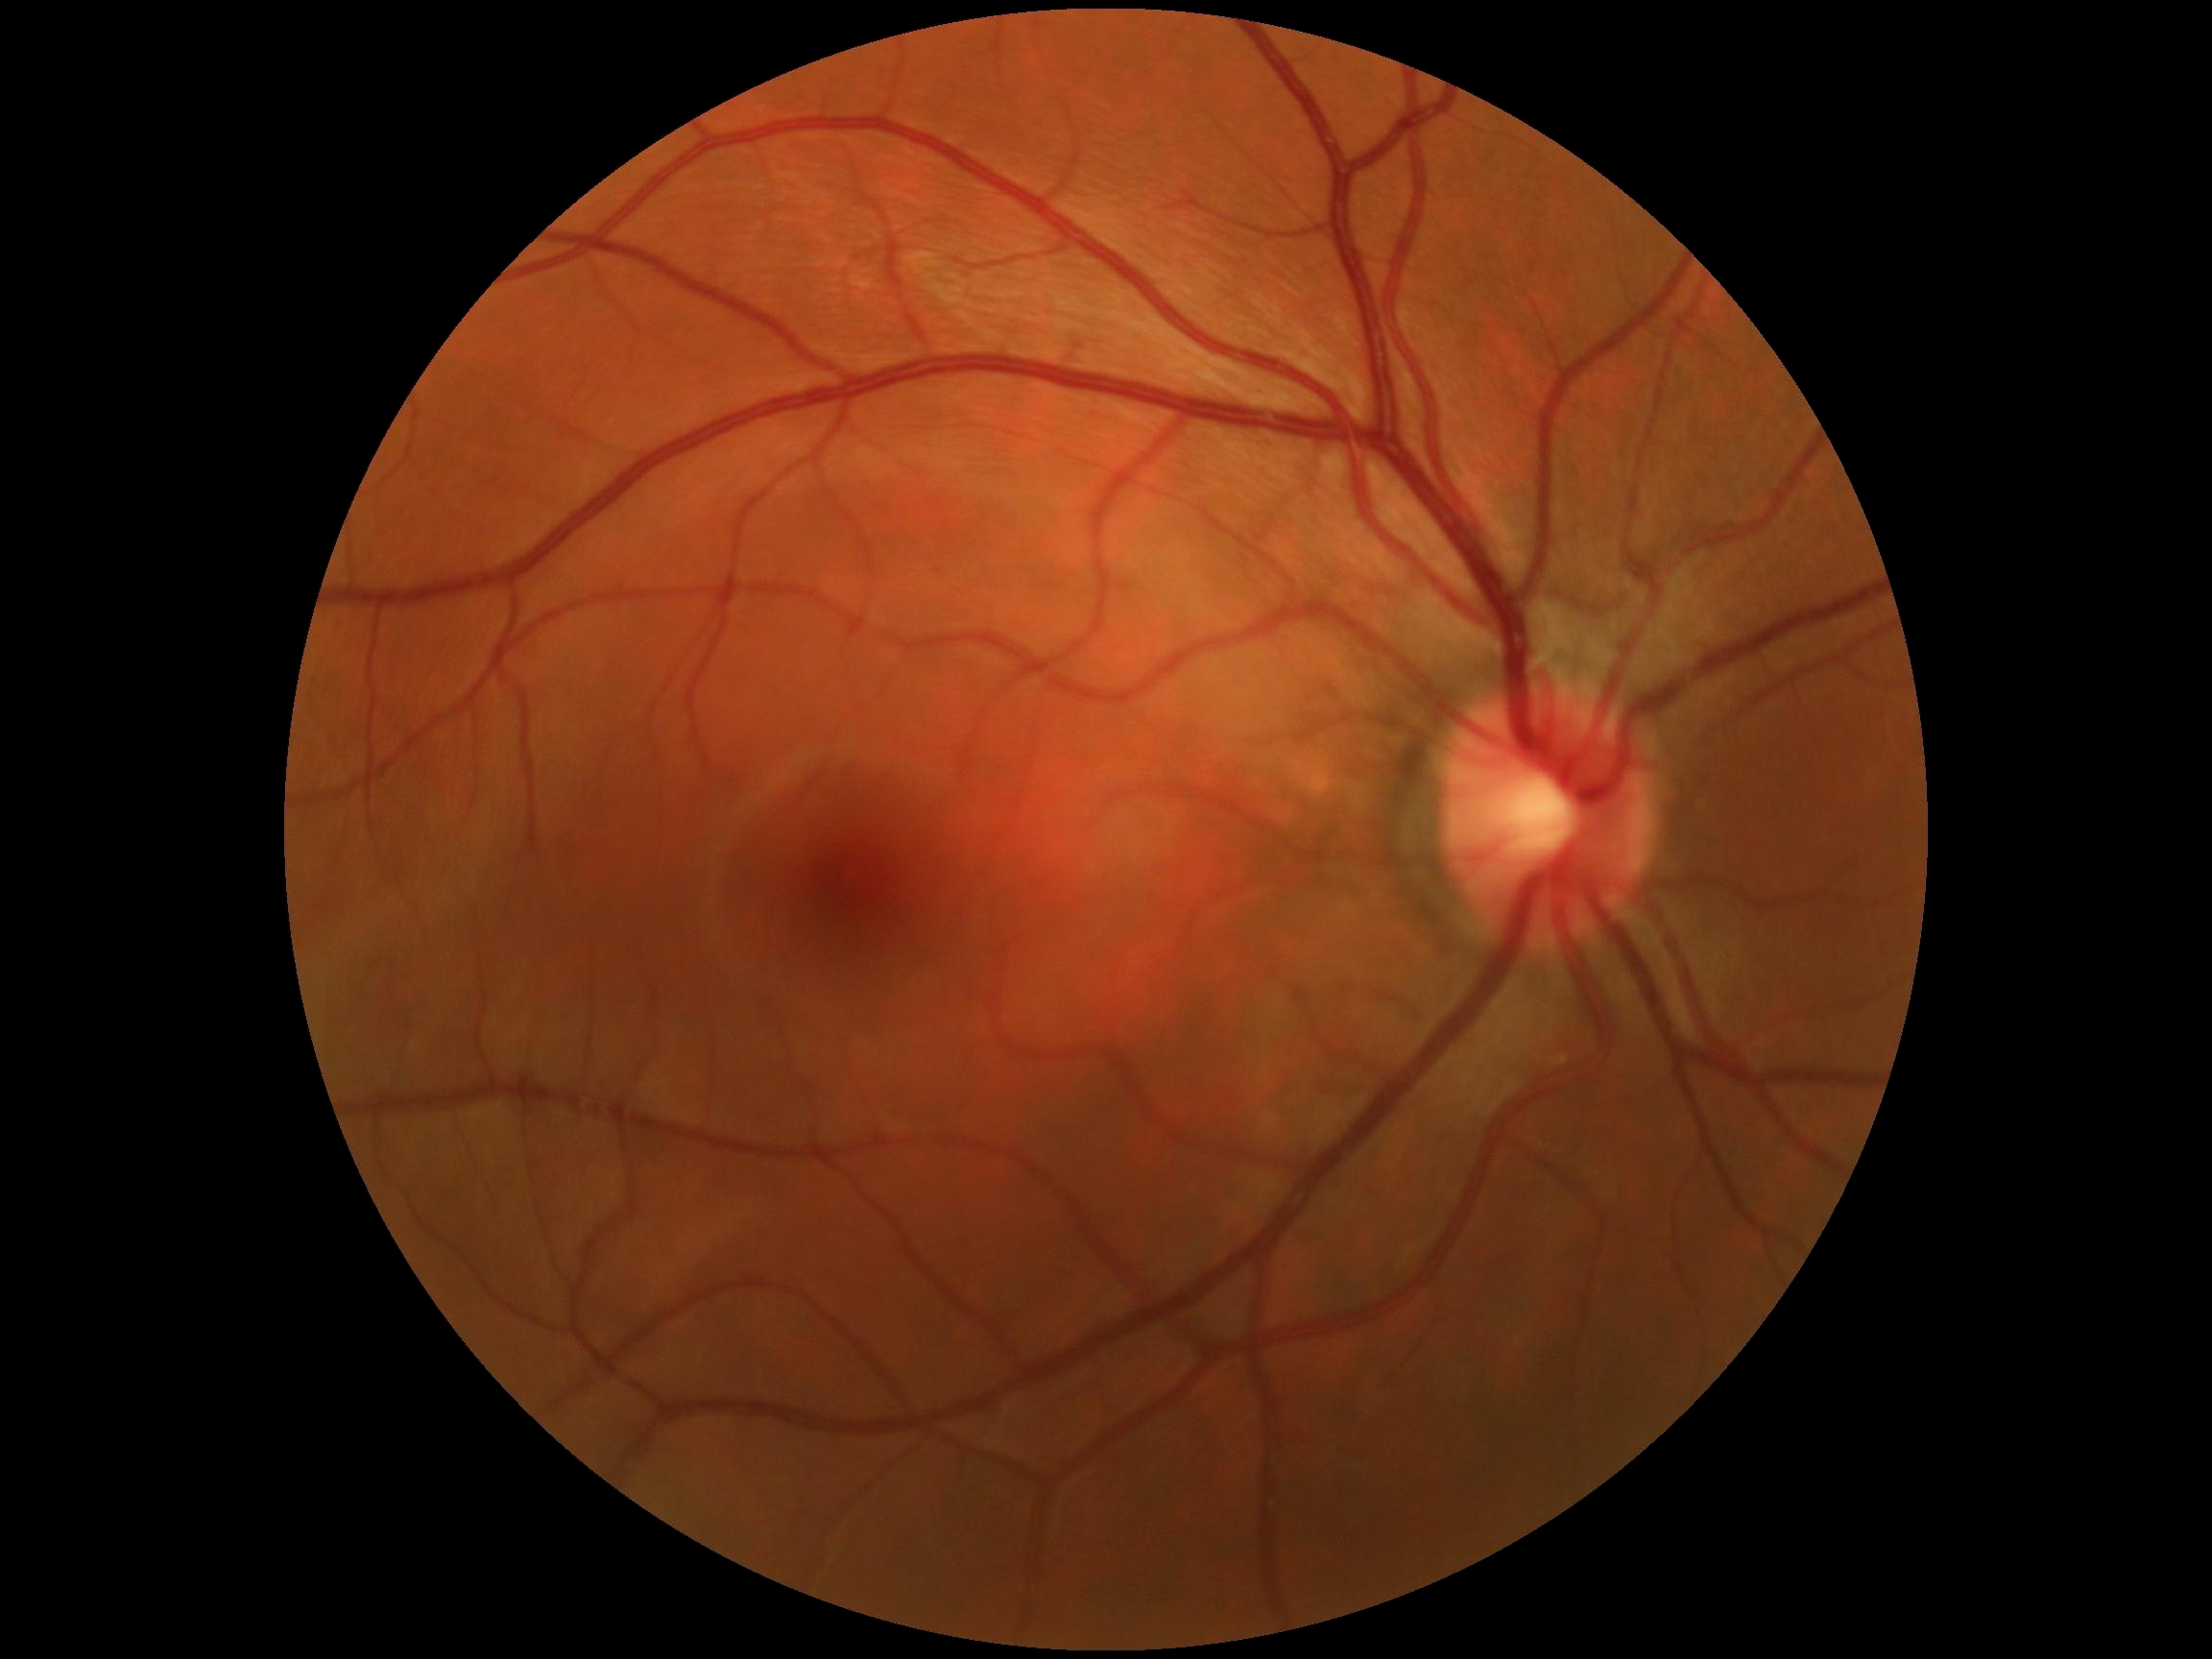

Diabetic retinopathy (DR): grade 0 (no apparent retinopathy) — no visible signs of diabetic retinopathy.
No signs of diabetic retinopathy.